Ultra-widefield fundus mosaic:
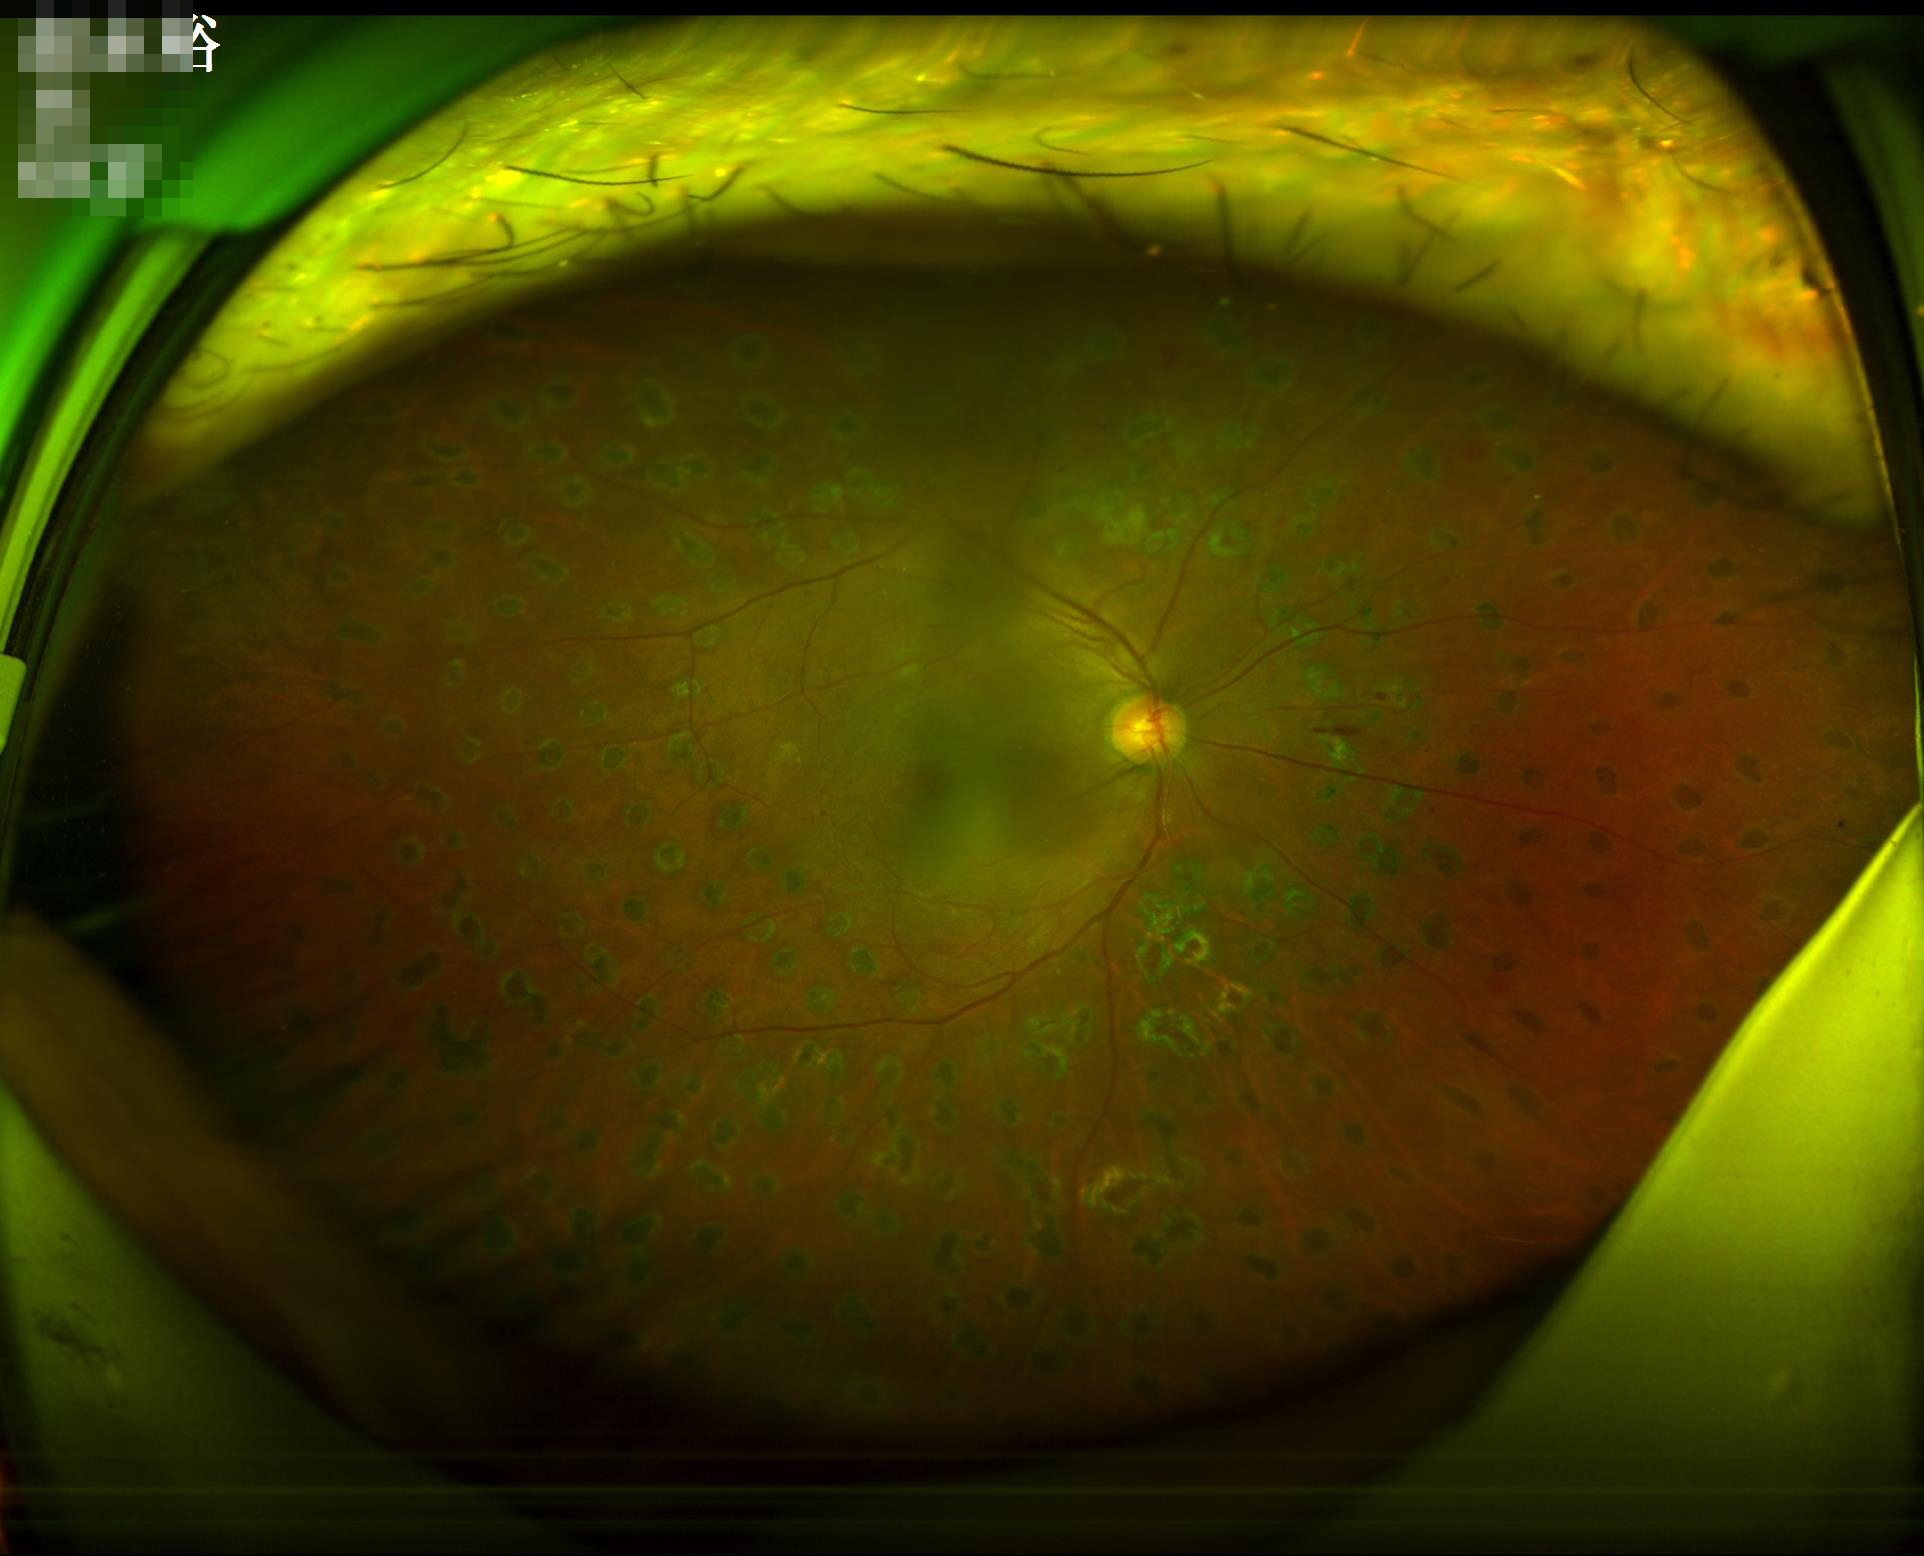

Overall quality = adequate | Illumination = adequate | Focus = out of focus.